45-degree field of view:
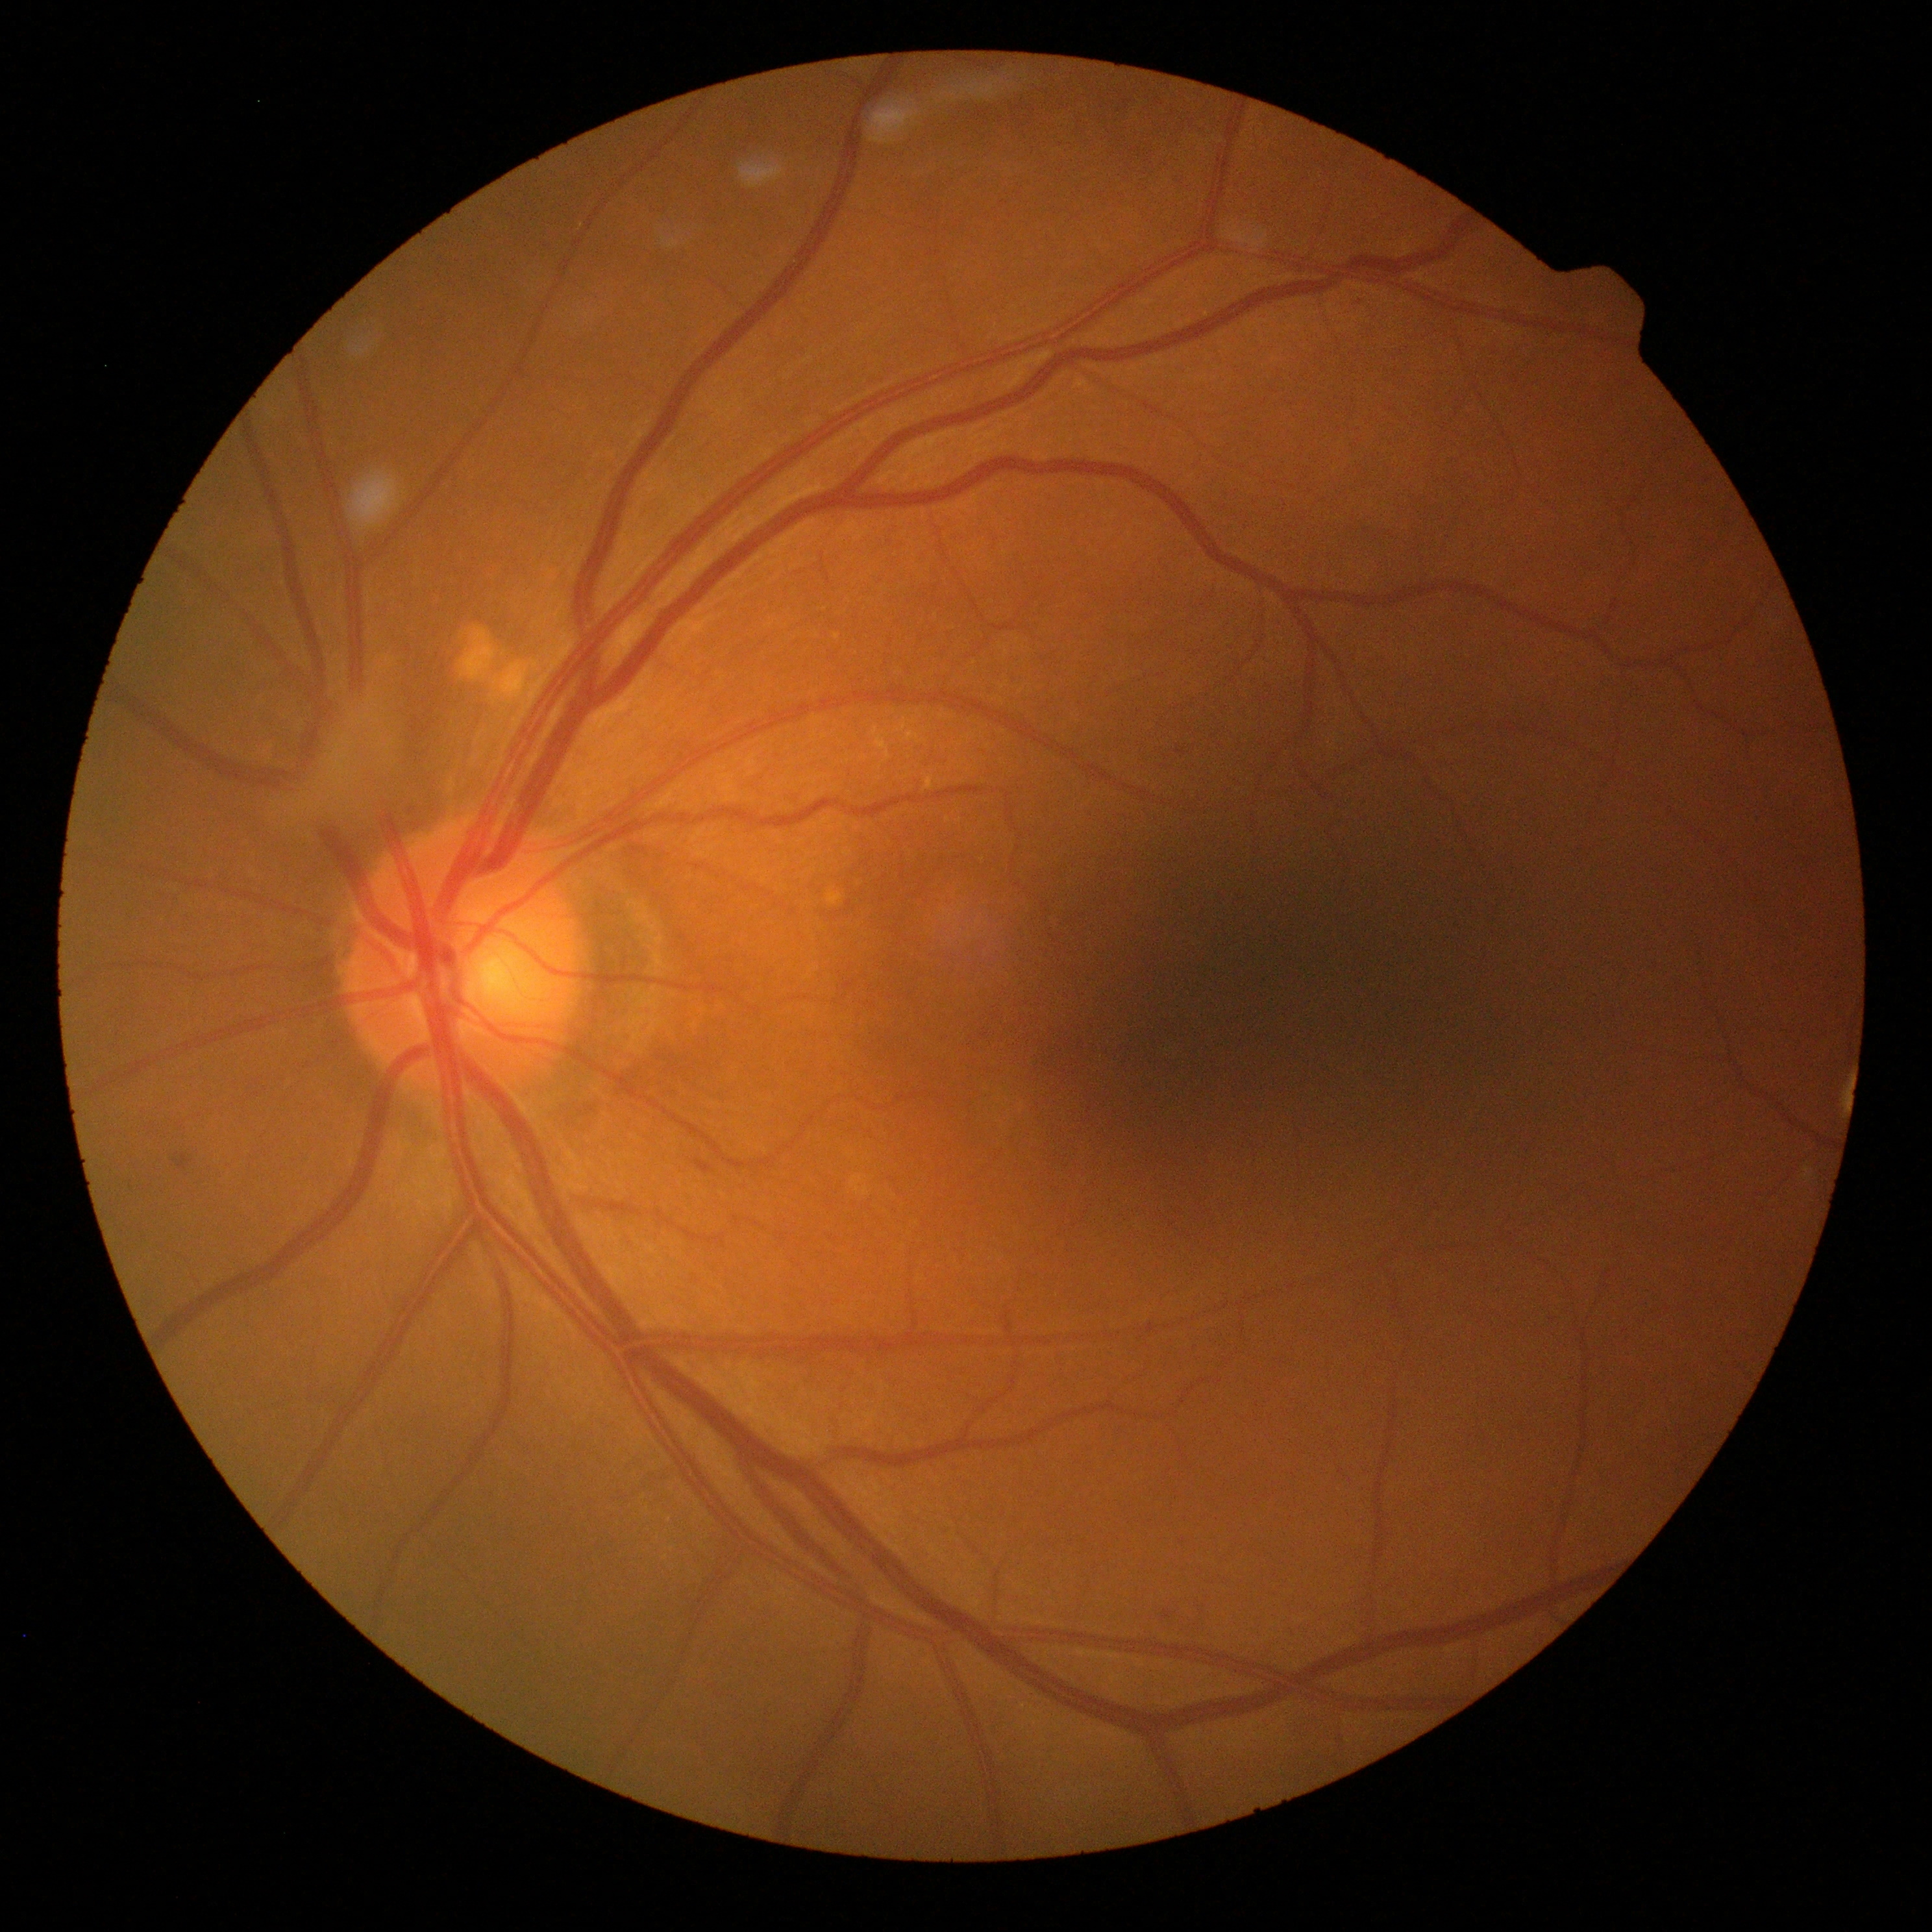 DR stage@mild NPDR (grade 1).